2048 x 1536 pixels; 45° field of view; retinal fundus photograph: 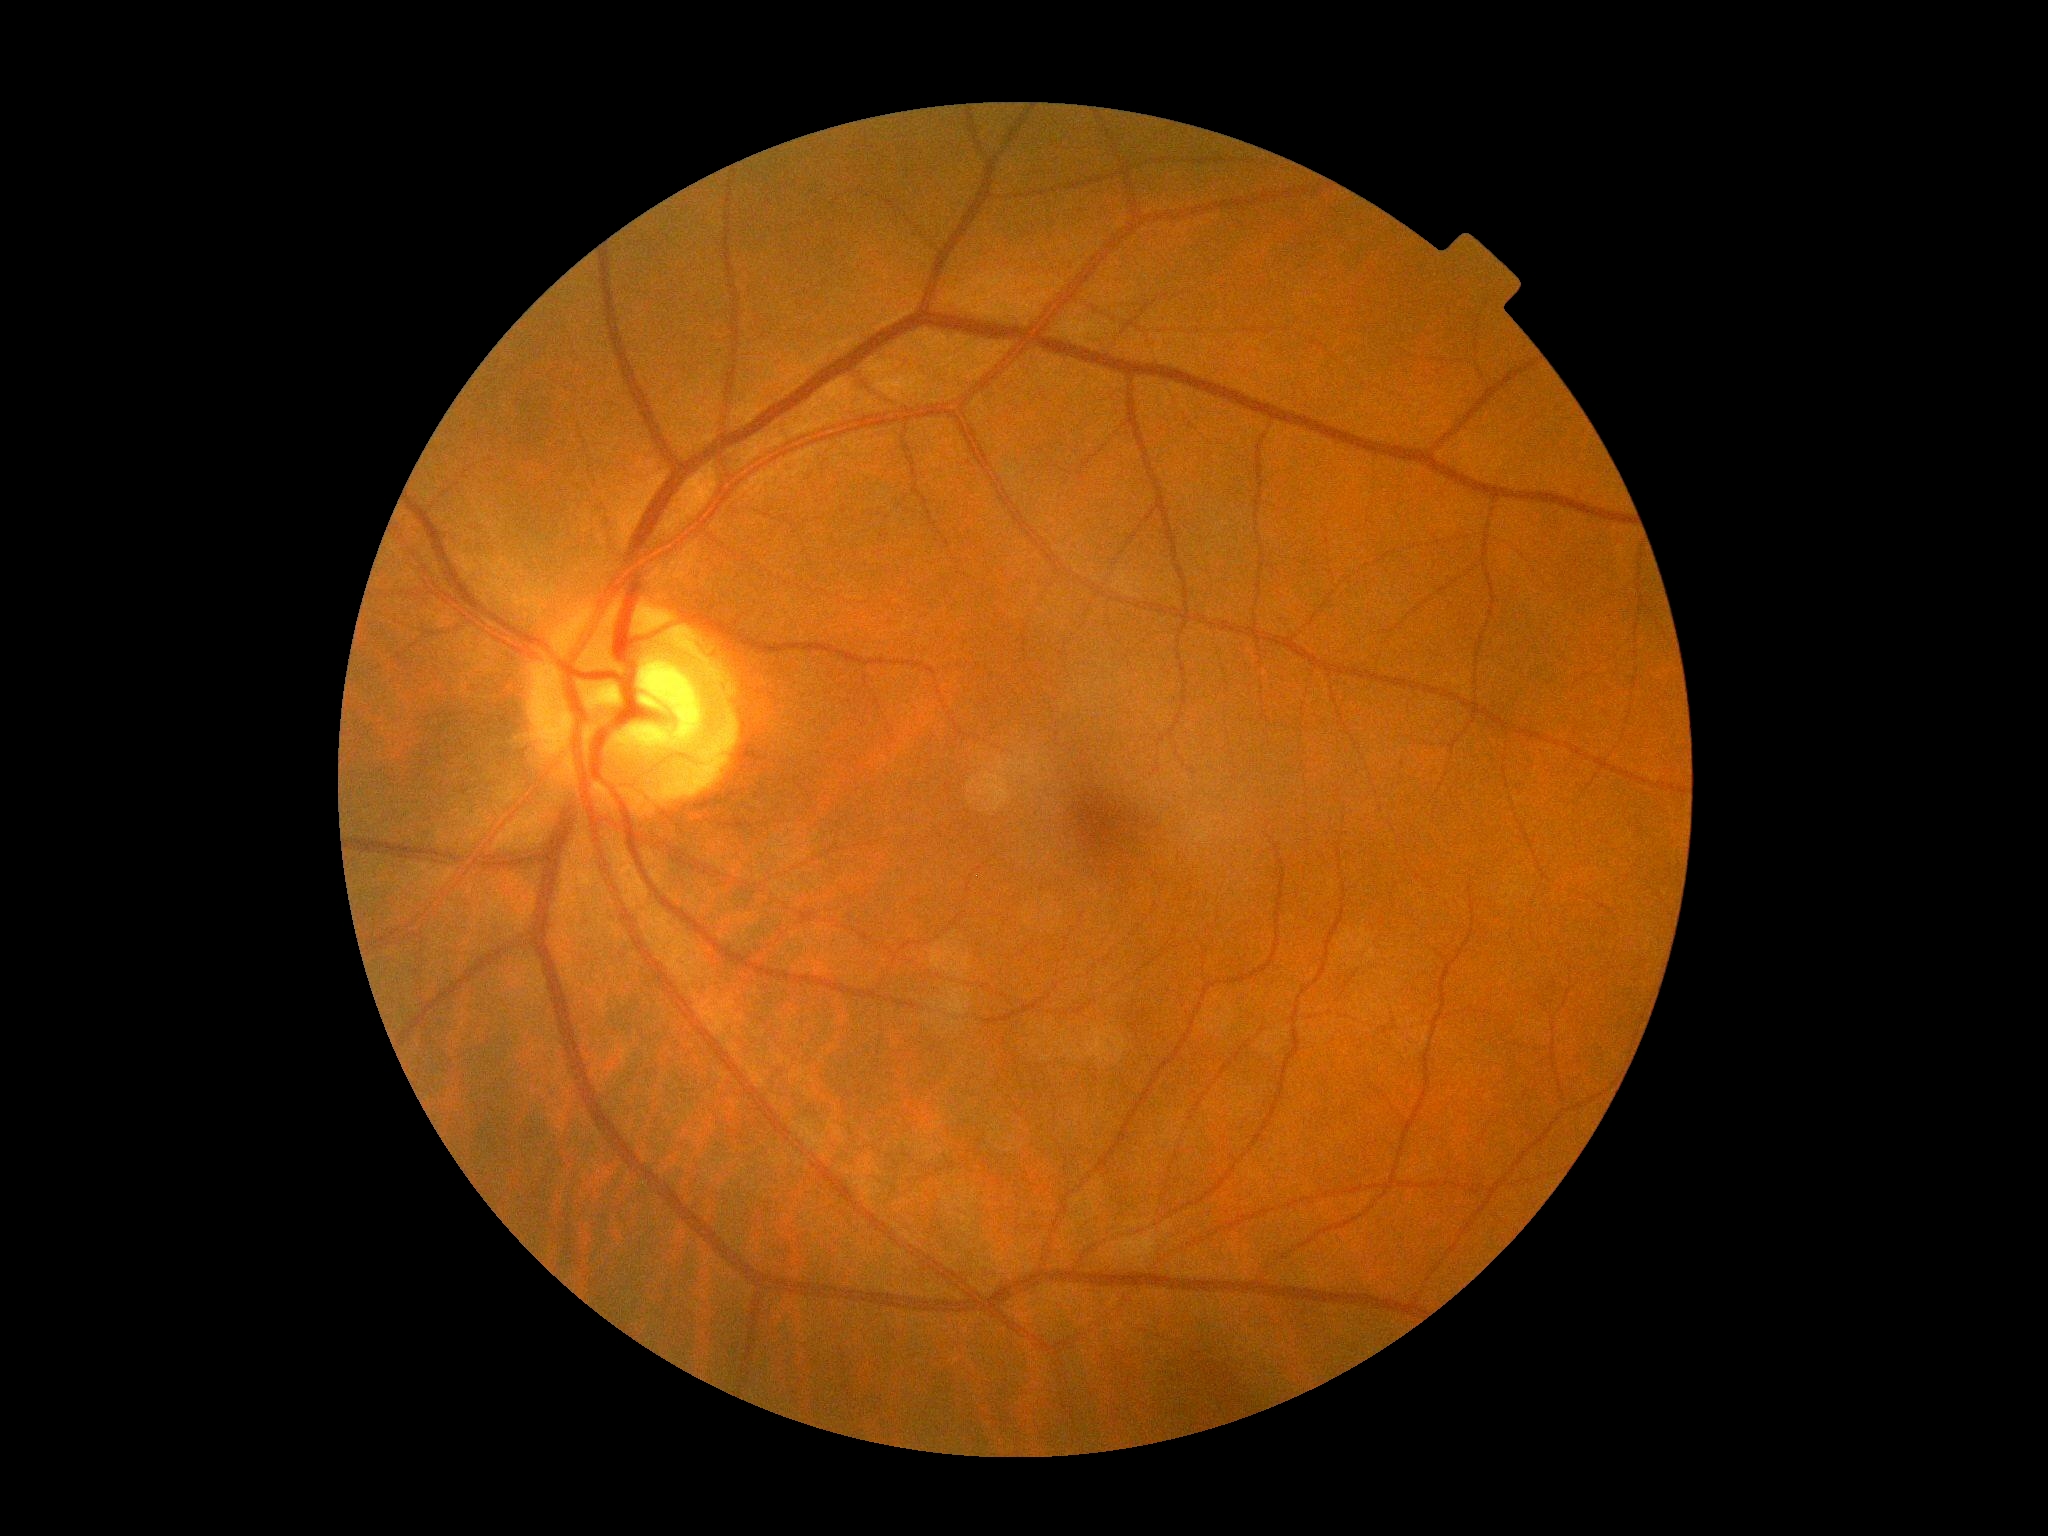
Diabetic retinopathy (DR): grade 0 (no apparent retinopathy).